Infant wide-field retinal image · captured with the Clarity RetCam 3 (130° field of view):
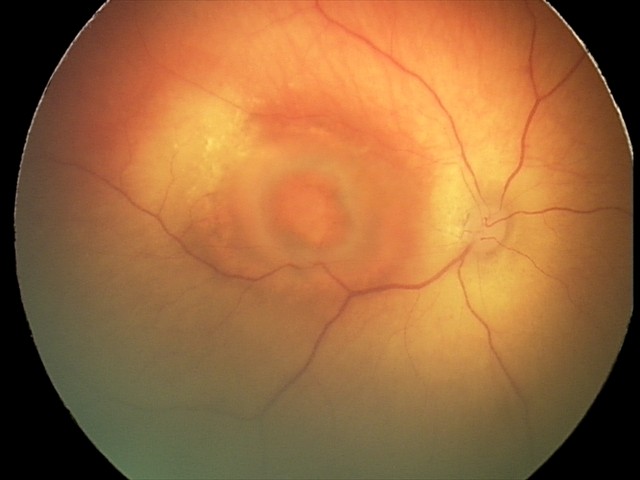

Screening series with toxoplasmosis chorioretinitis.